Fundus photo: 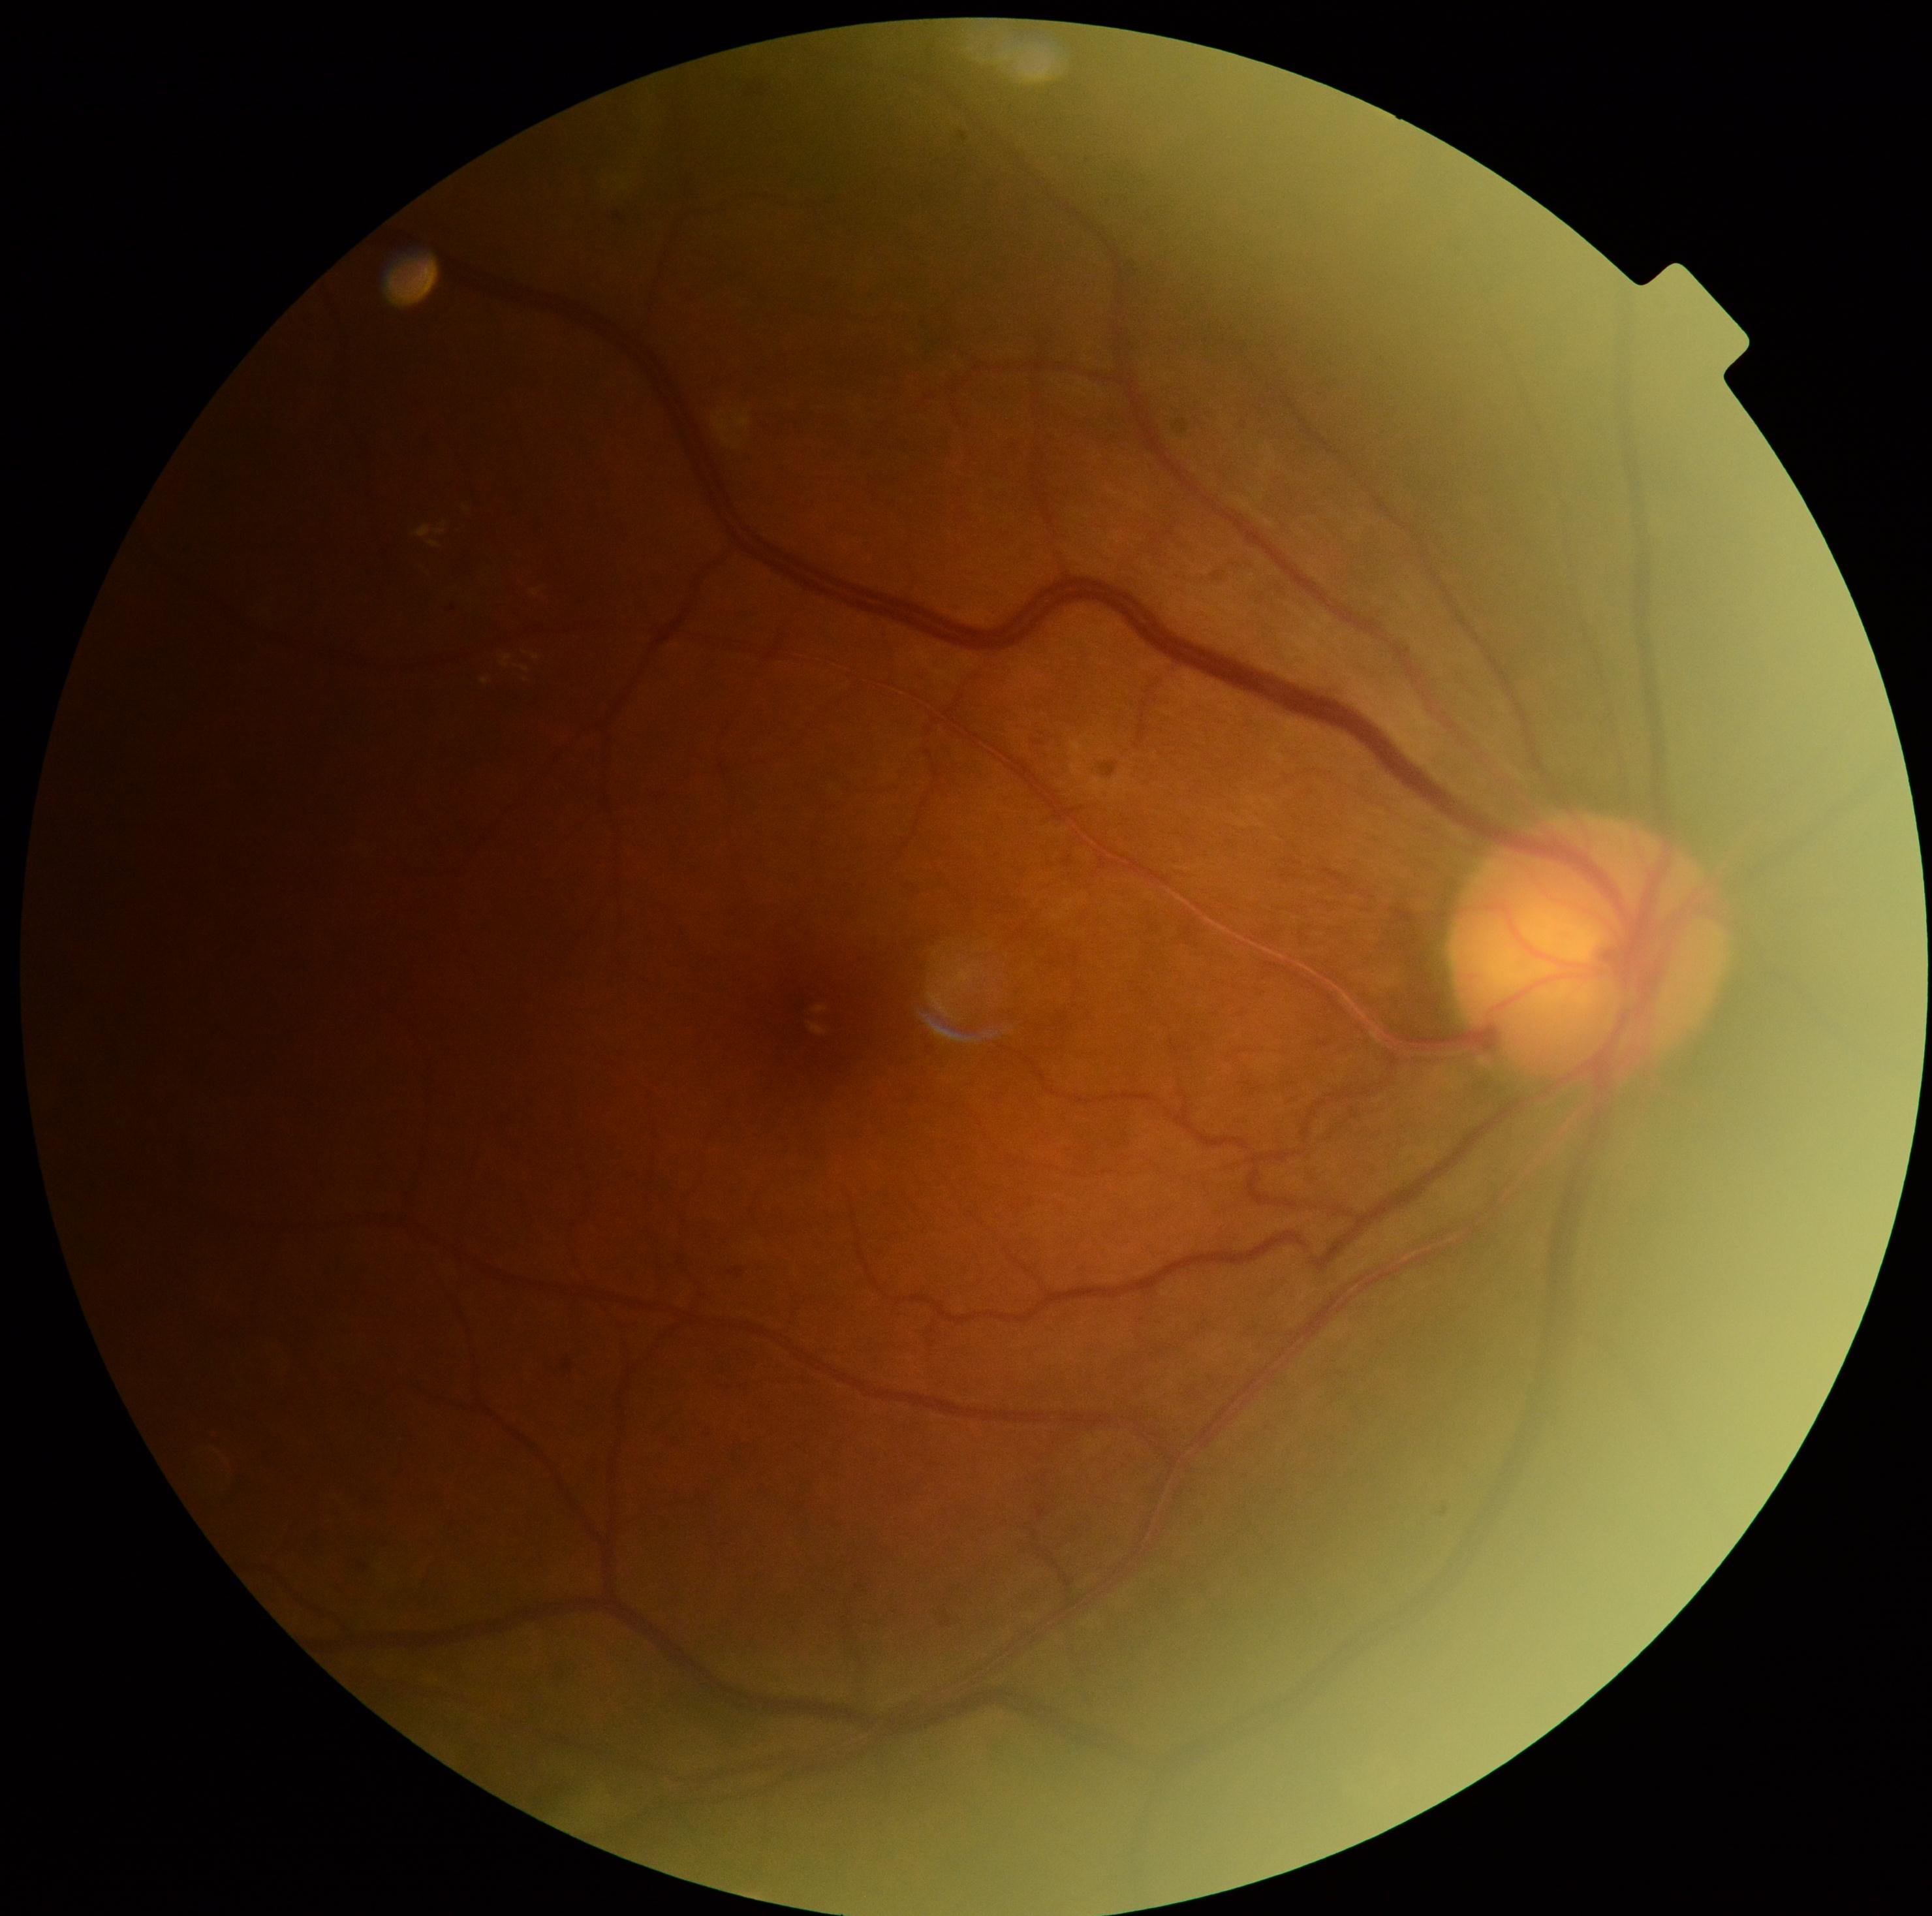 Diabetic retinopathy (DR): grade 2 (moderate NPDR) — more than just microaneurysms but less than severe NPDR.